CFP; 45-degree field of view:
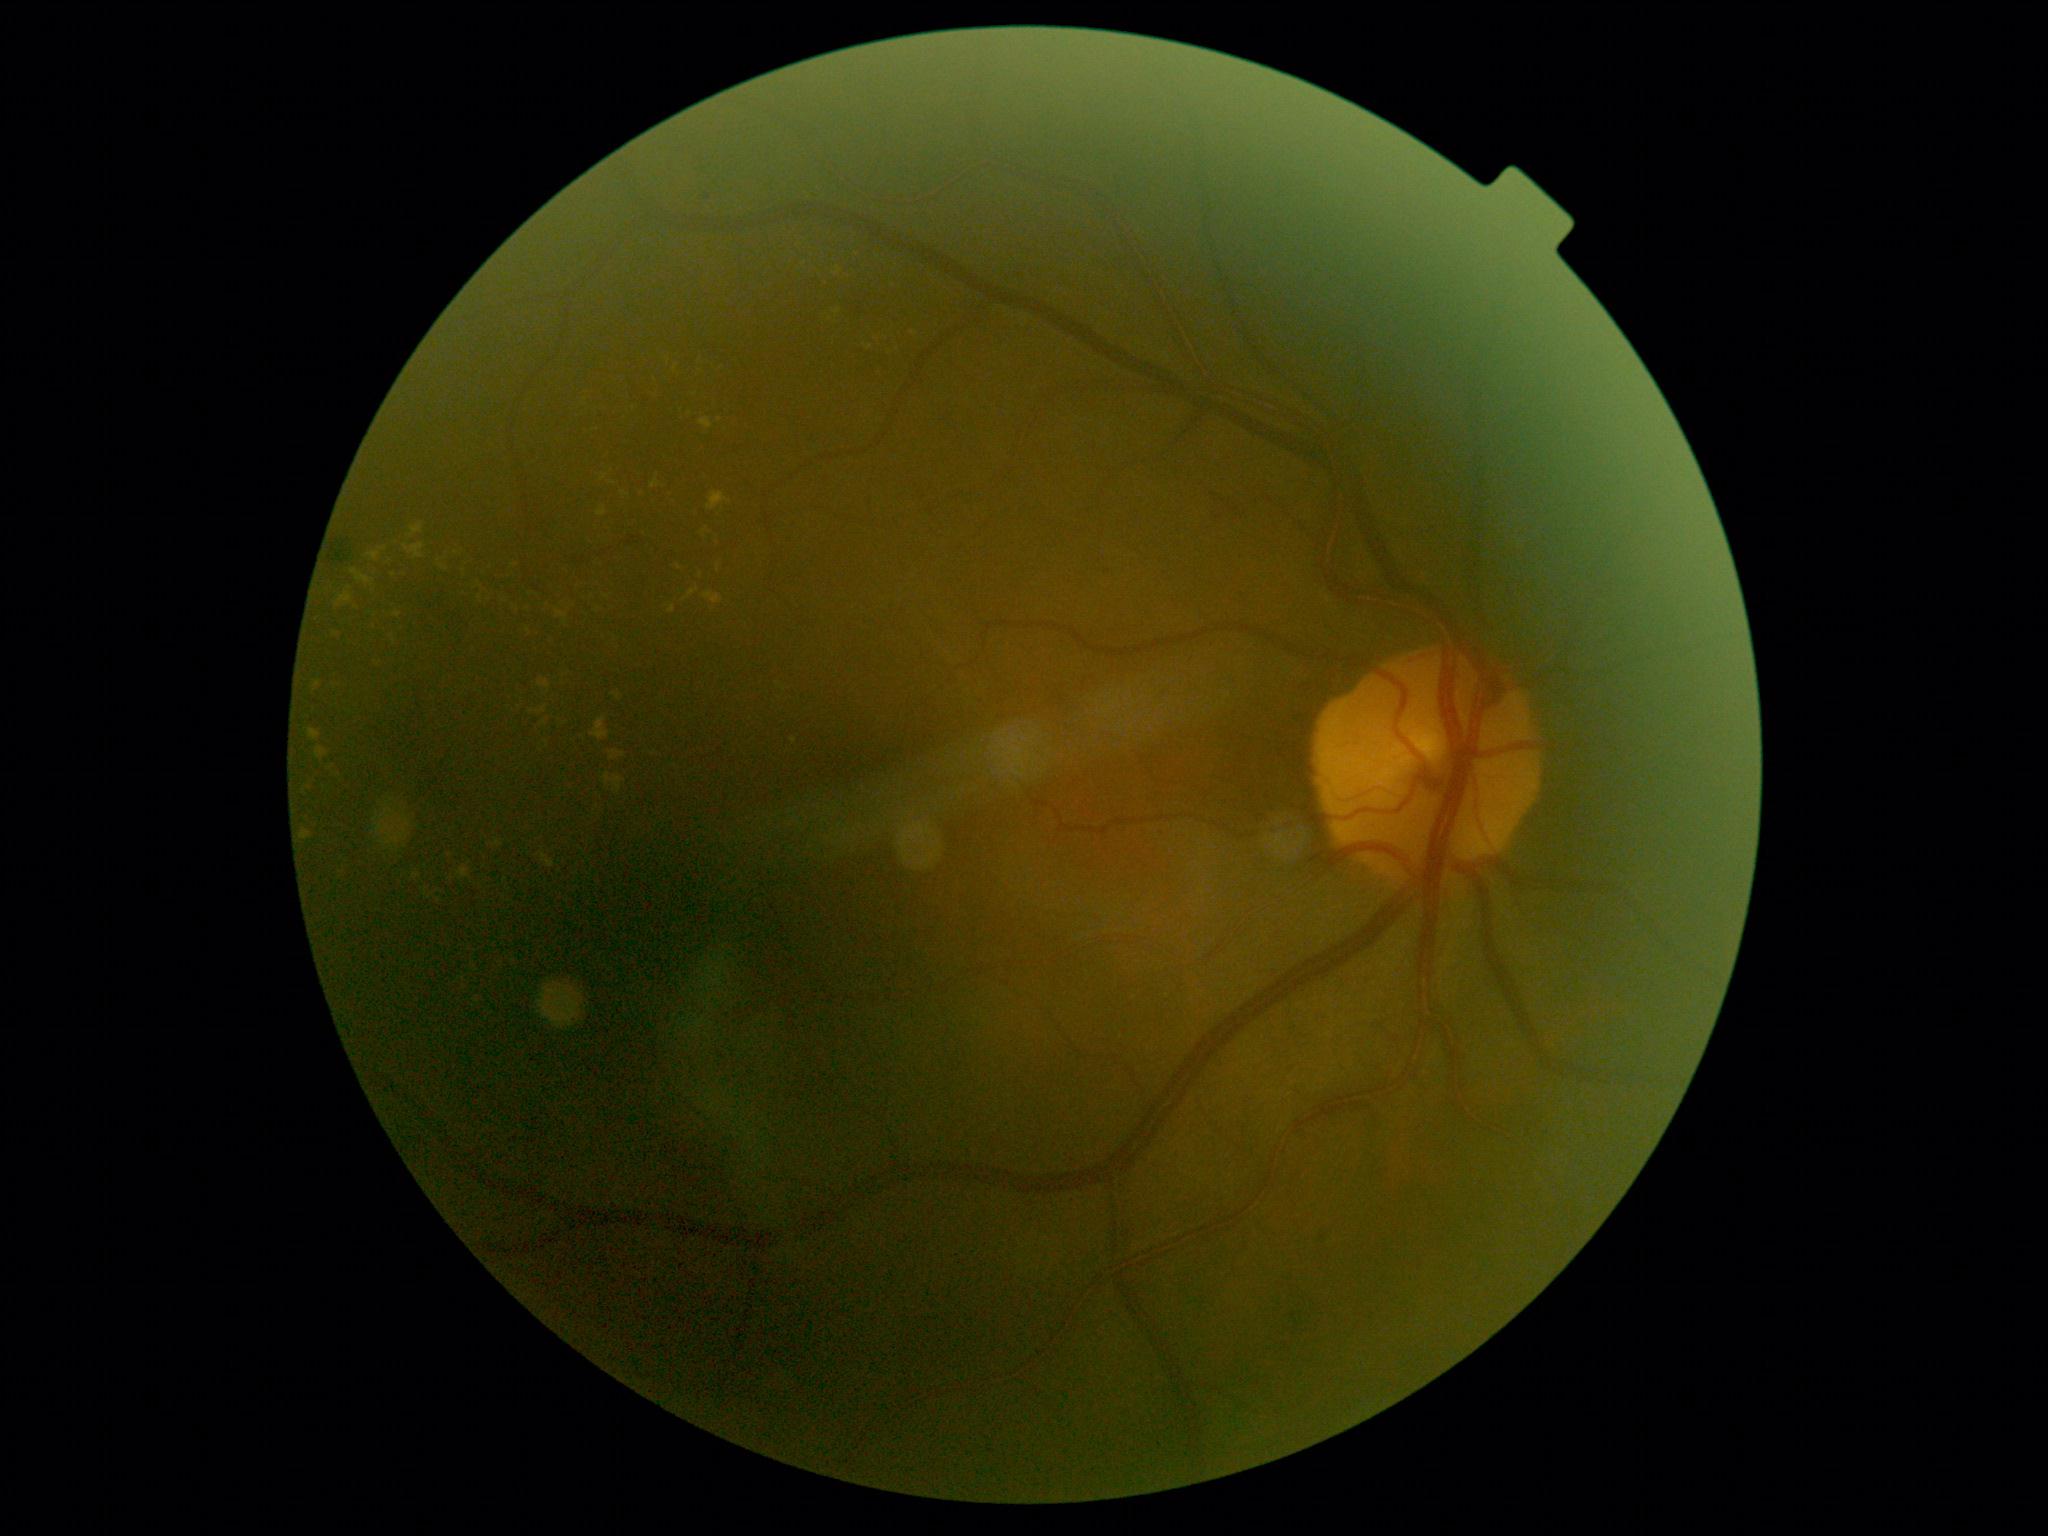
Disease class: non-proliferative diabetic retinopathy. Diabetic retinopathy grade: 2 — more than just microaneurysms but less than severe NPDR.